Color fundus image · 2352 x 1568 pixels:
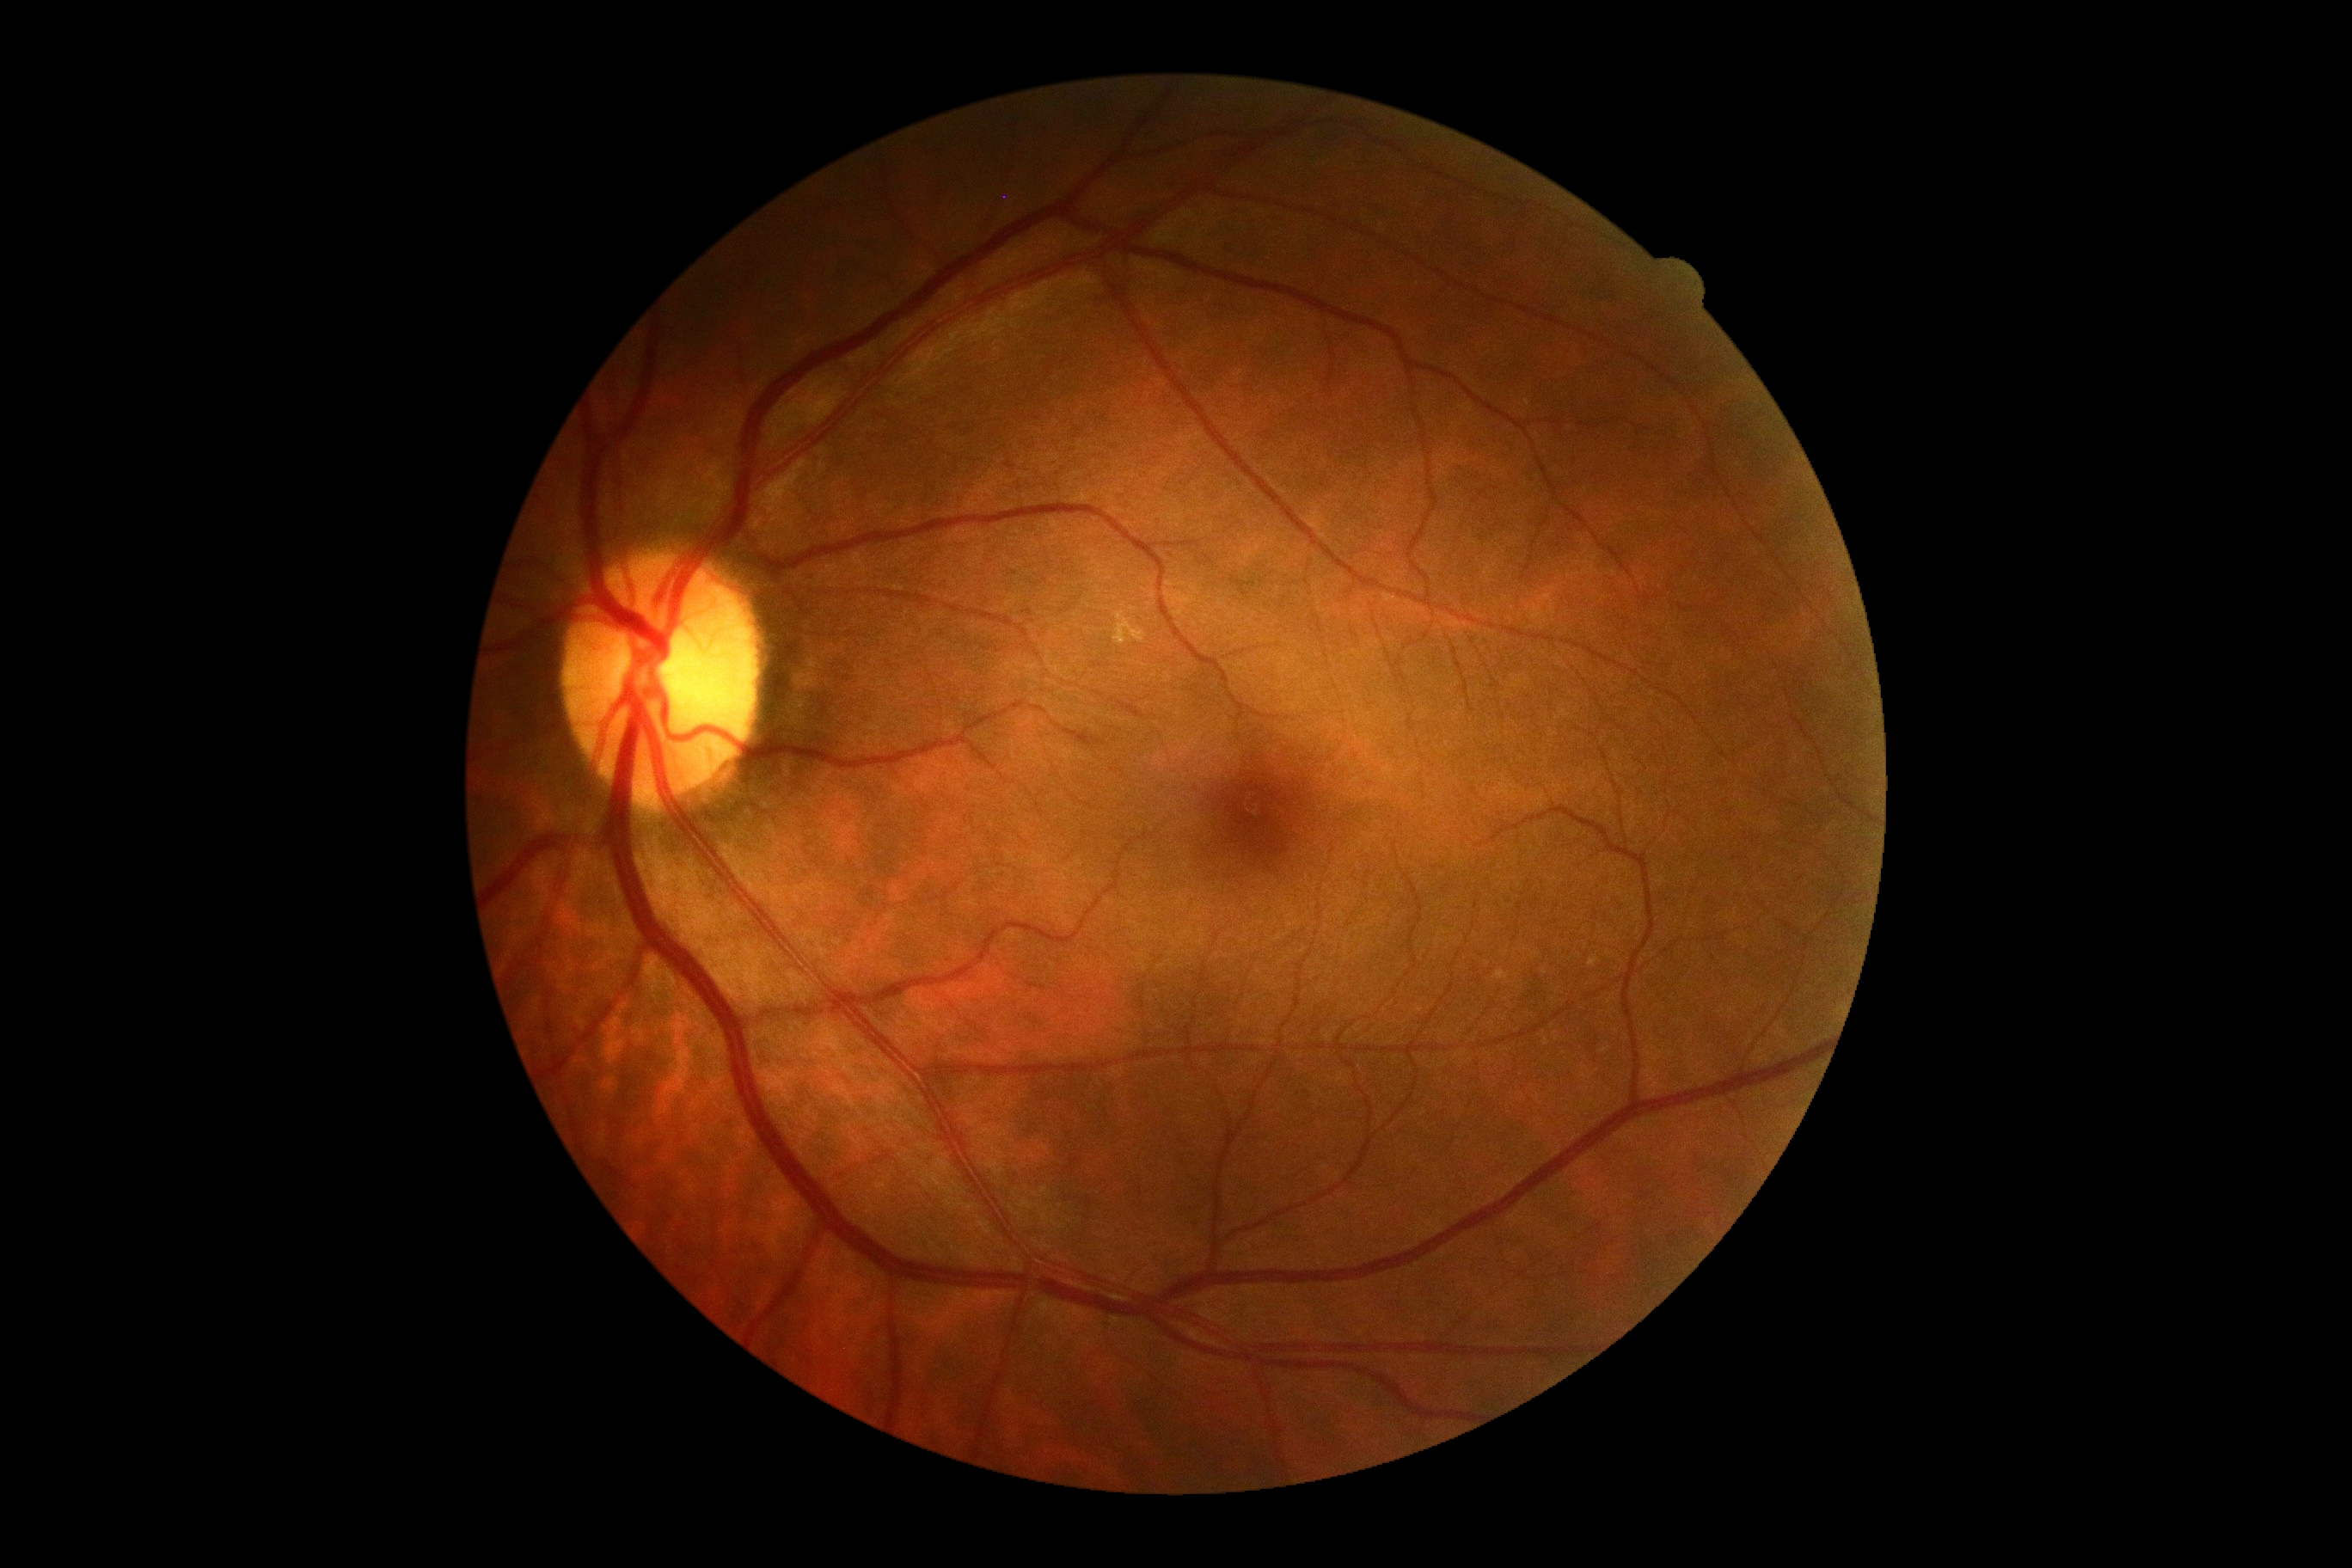 DR severity = 0/4.